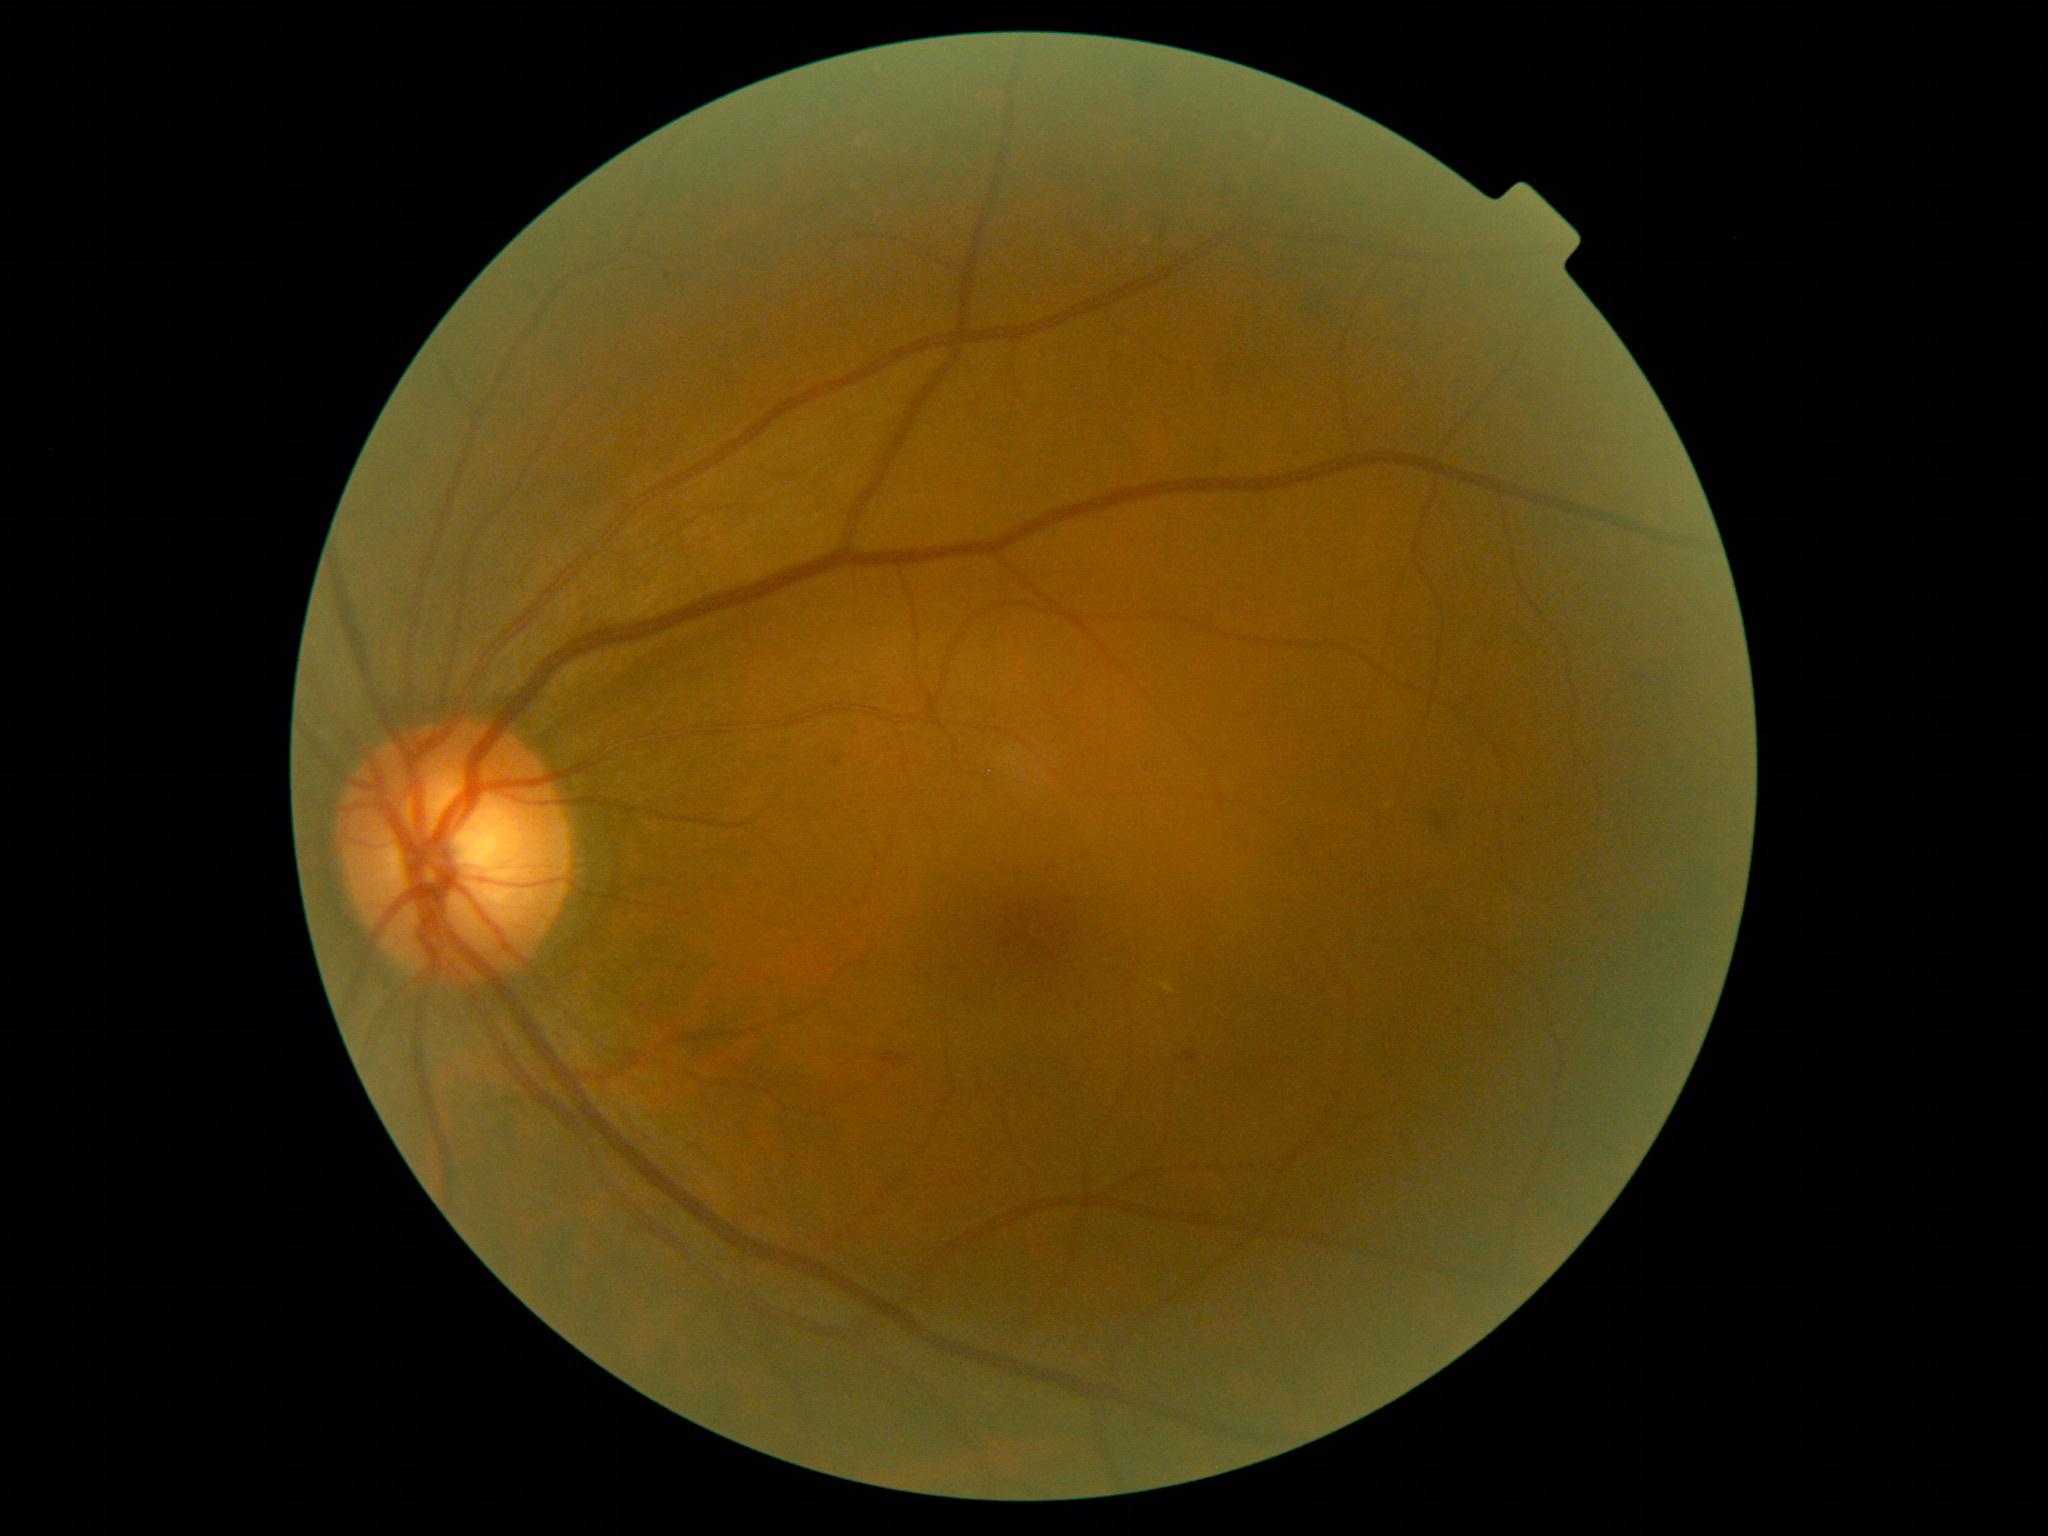

The retinopathy is classified as non-proliferative diabetic retinopathy.
DR is moderate NPDR (grade 2).